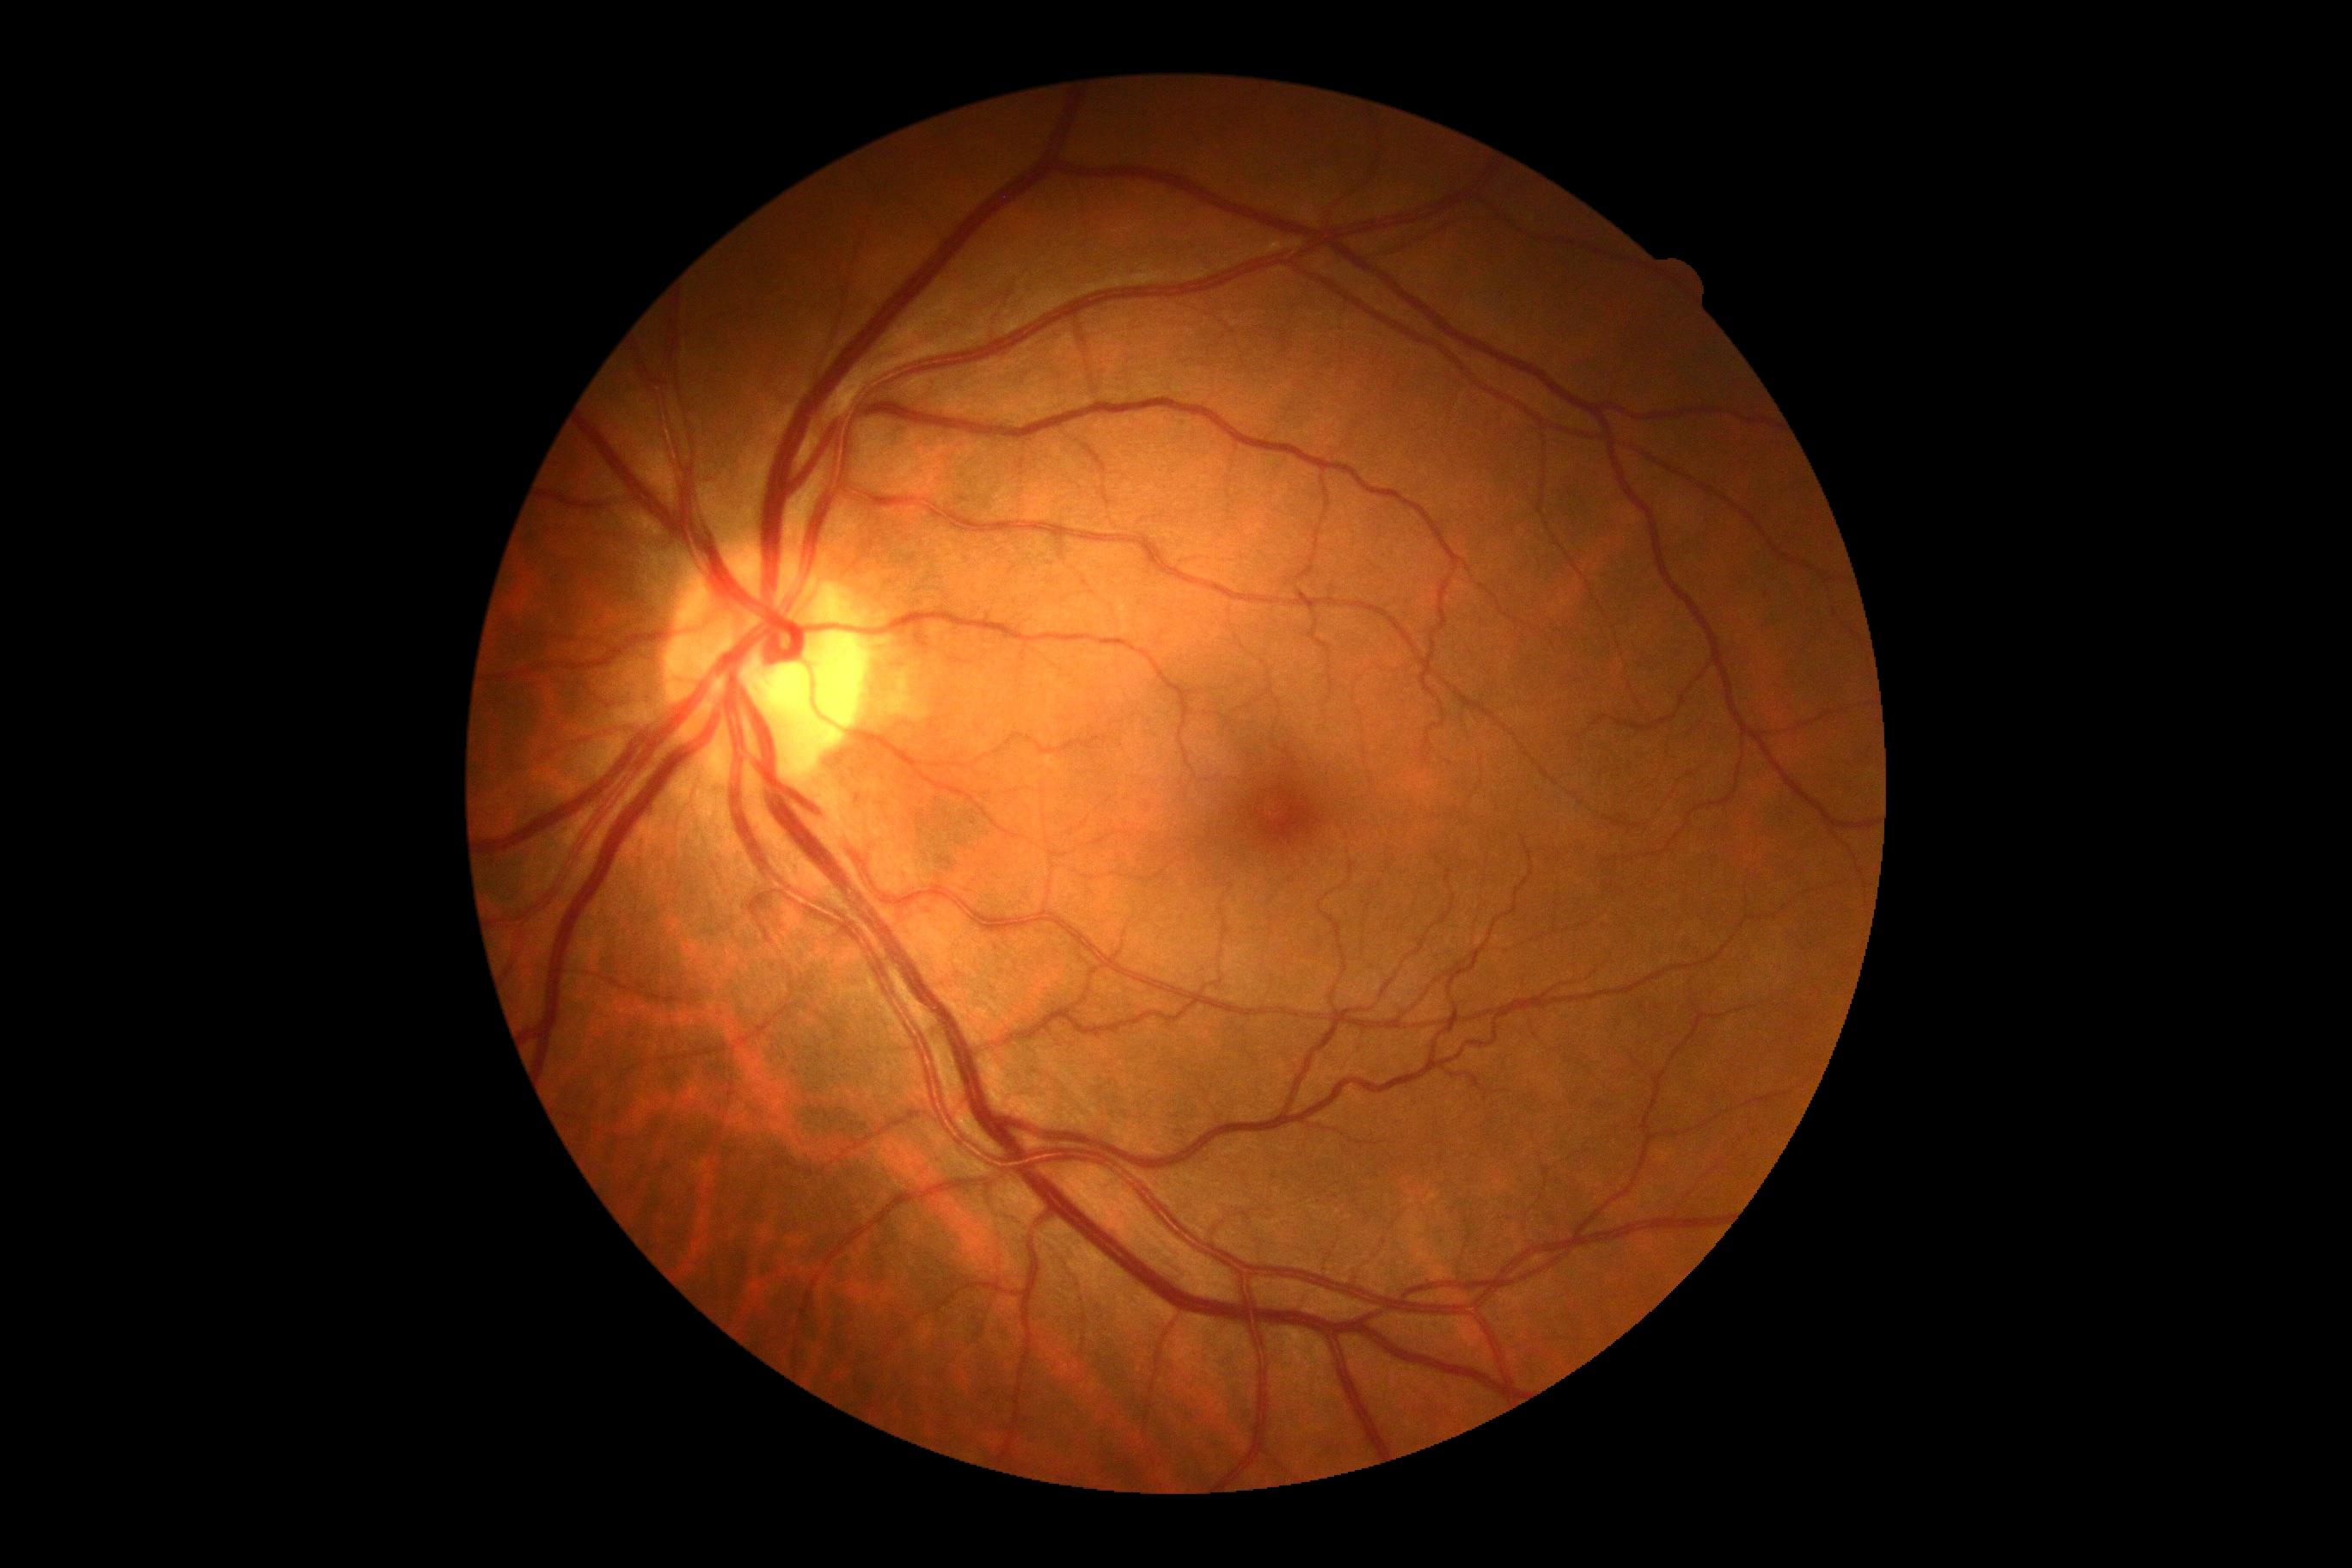

  dr_grade: no apparent diabetic retinopathy (grade 0)
  dr_impression: no signs of DR